Posterior pole color fundus photograph · 848 x 848 pixels:
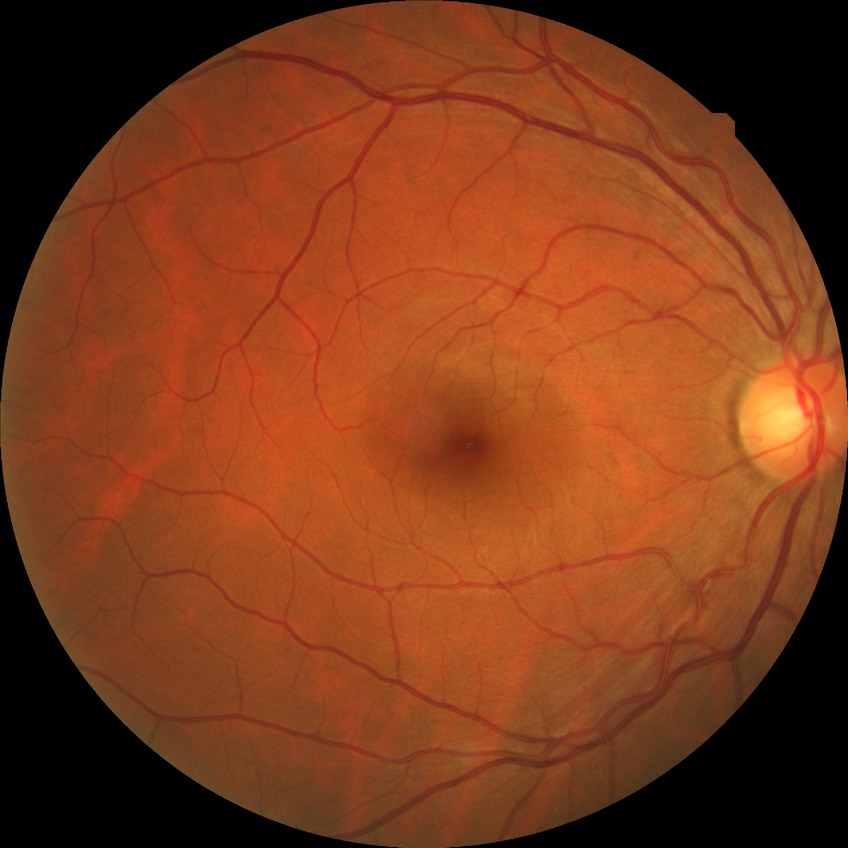
Diabetic retinopathy severity: no diabetic retinopathy.